Ultra-widefield fundus mosaic: 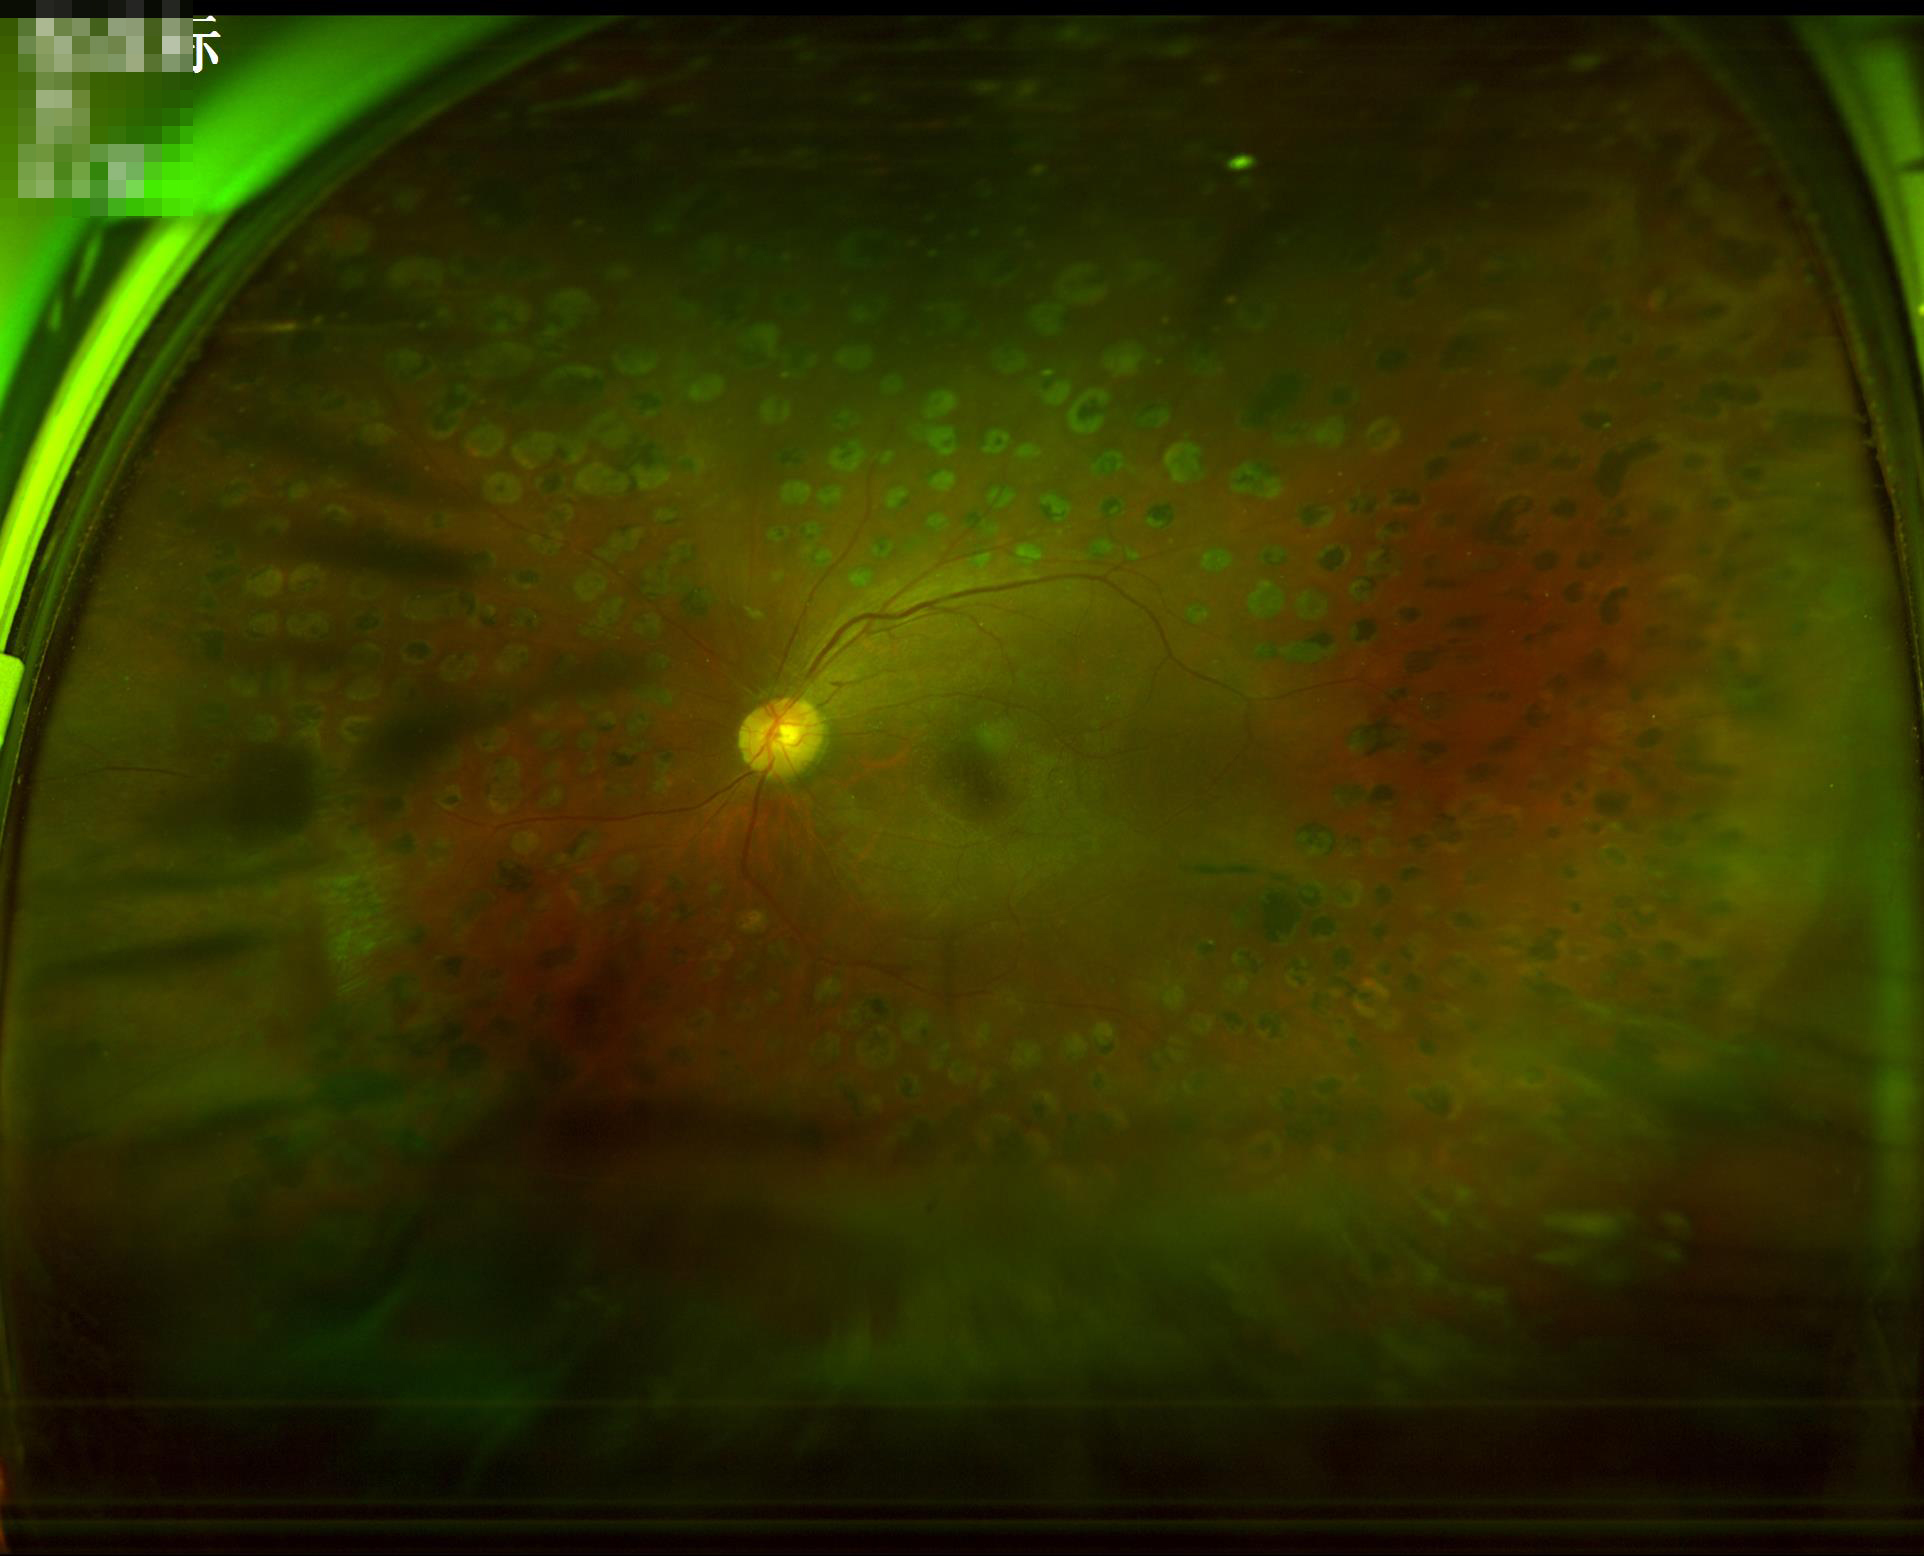

Poor illumination with uneven exposure. Overall quality is poor; the image is difficult to grade. Out of focus; structures are indistinct. Contrast is good.